Acquired with a NIDEK AFC-230. 848 x 848 pixels.
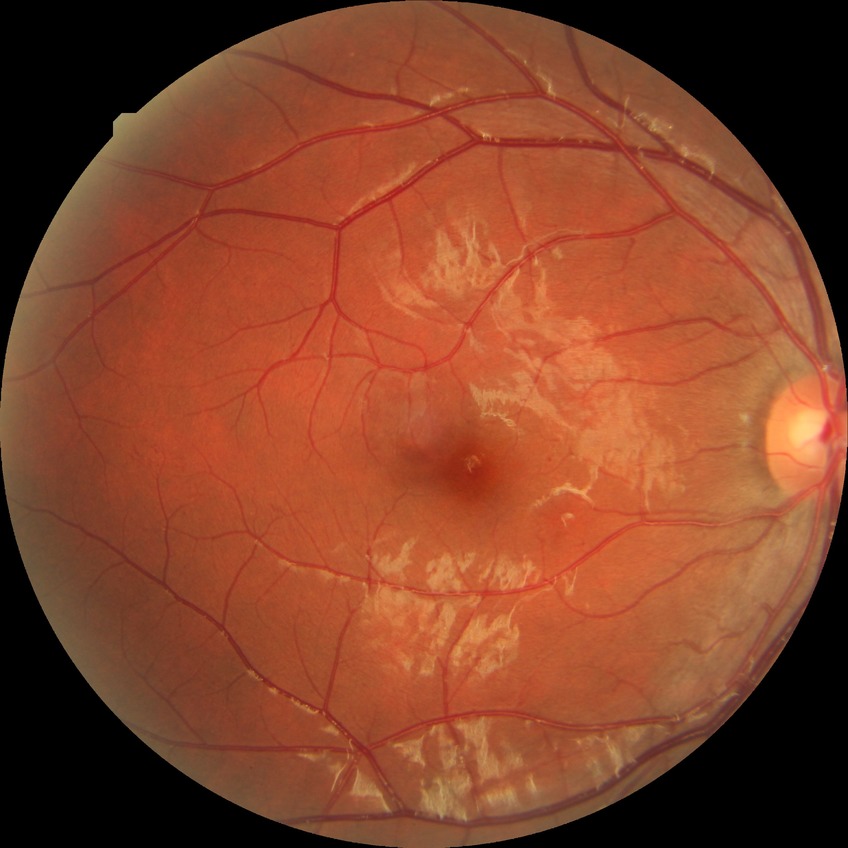
Diabetic retinopathy (DR): simple diabetic retinopathy (SDR).